640 x 480 pixels · wide-field contact fundus photograph of an infant: 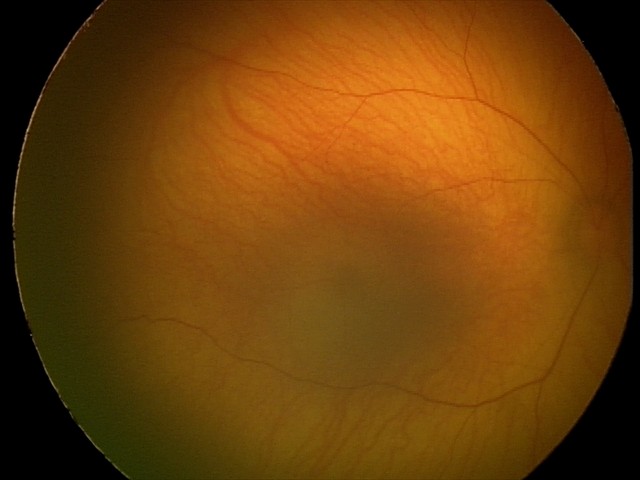
Screening diagnosis: retinal hemorrhages.